Captured on a Bosch fundus camera
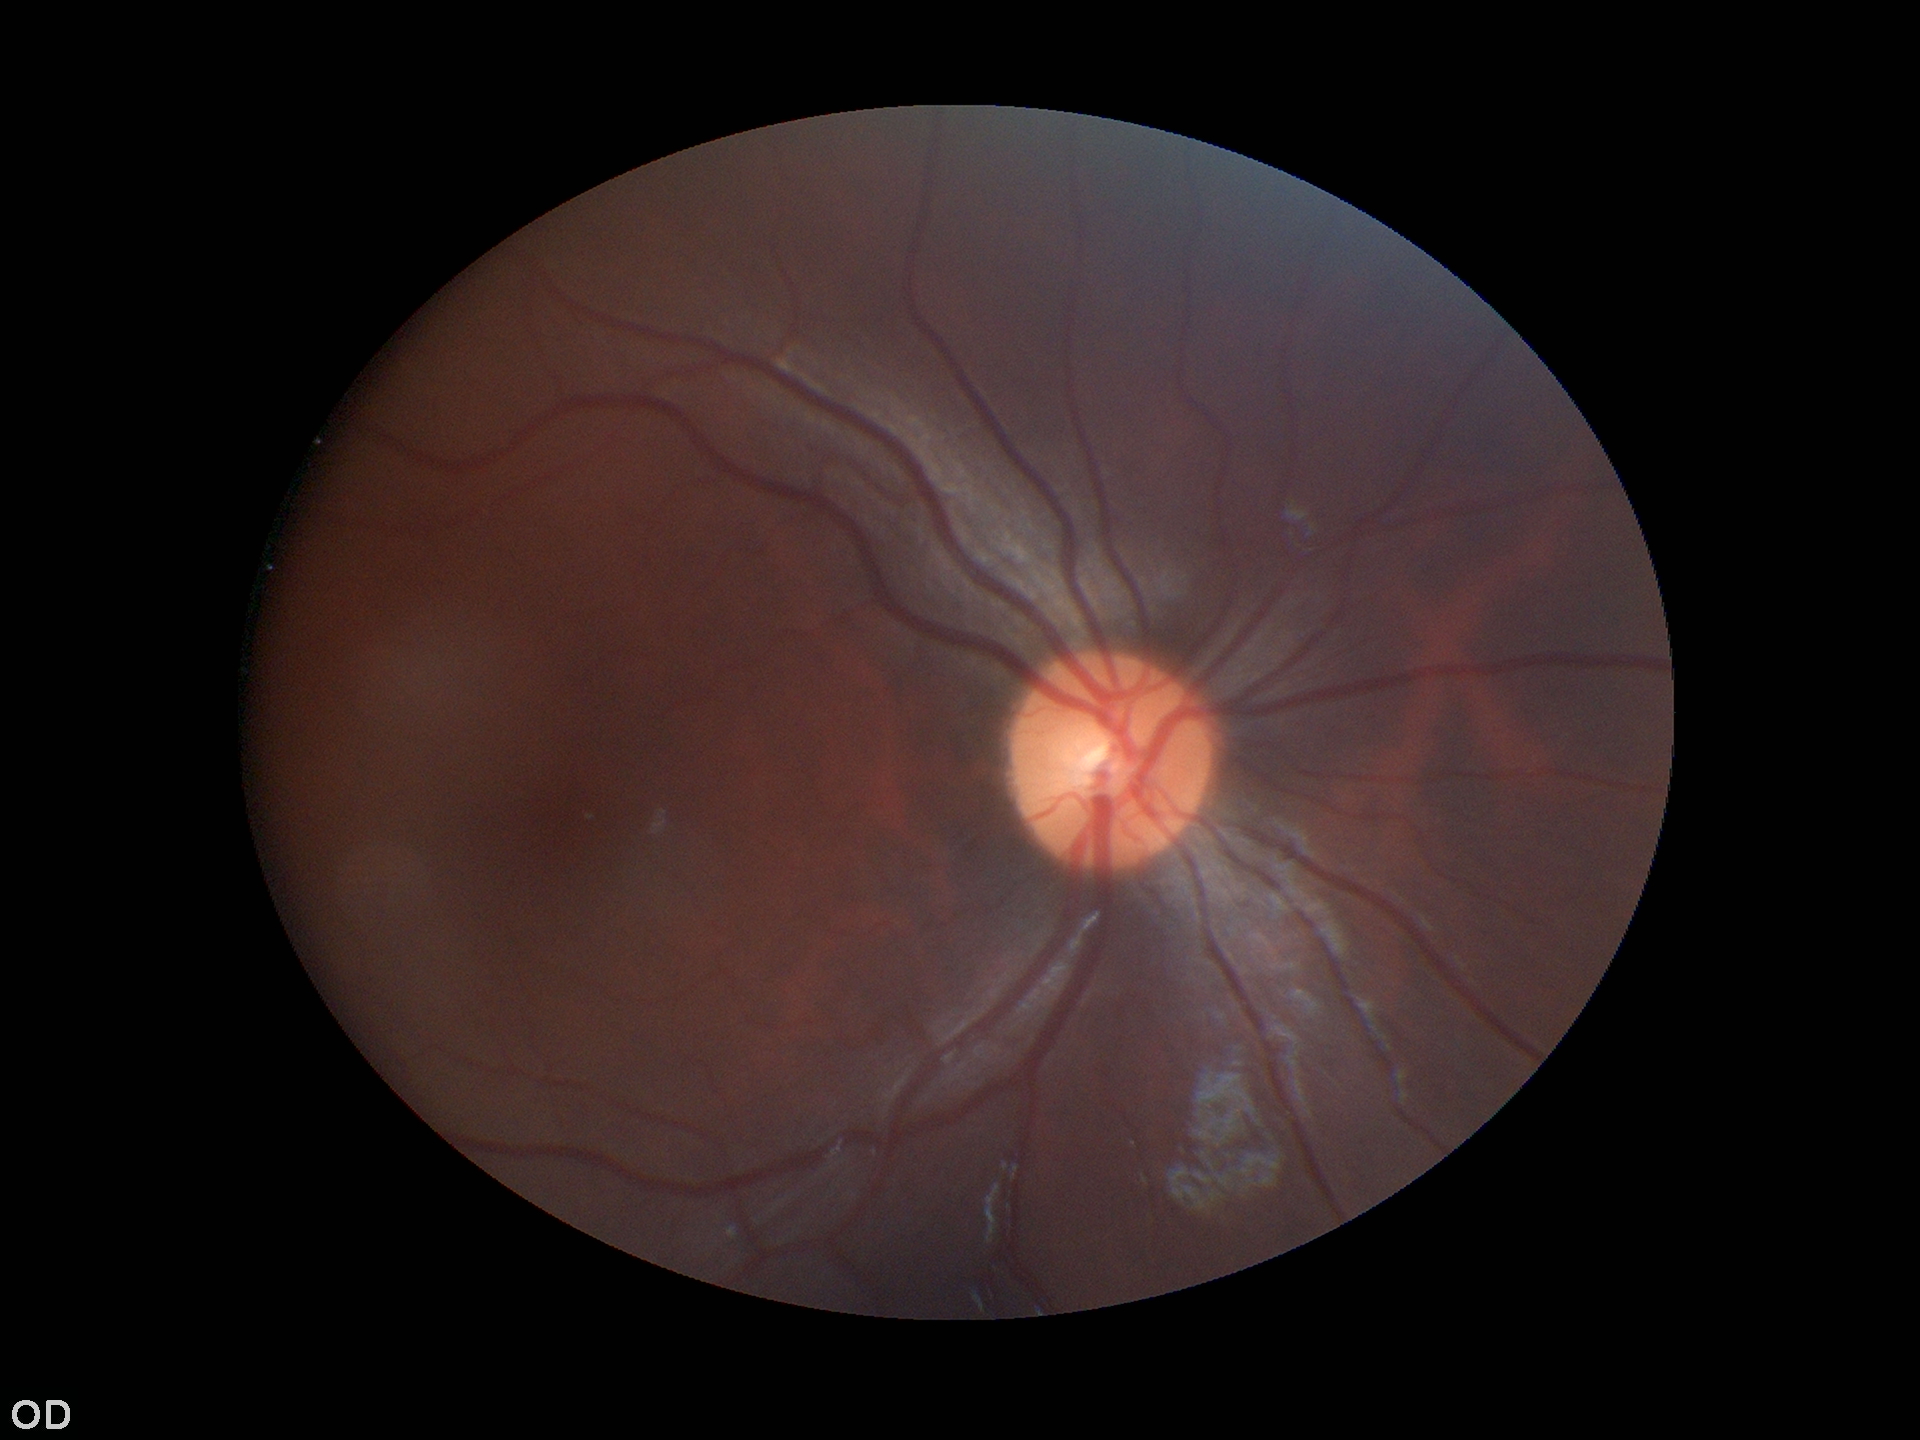 Horizontal cup-to-disc ratio is 0.45.
Vertical C/D ratio: 0.44.
No signs of glaucoma.